1440 x 1080 pixels. Wide-field contact fundus photograph of an infant
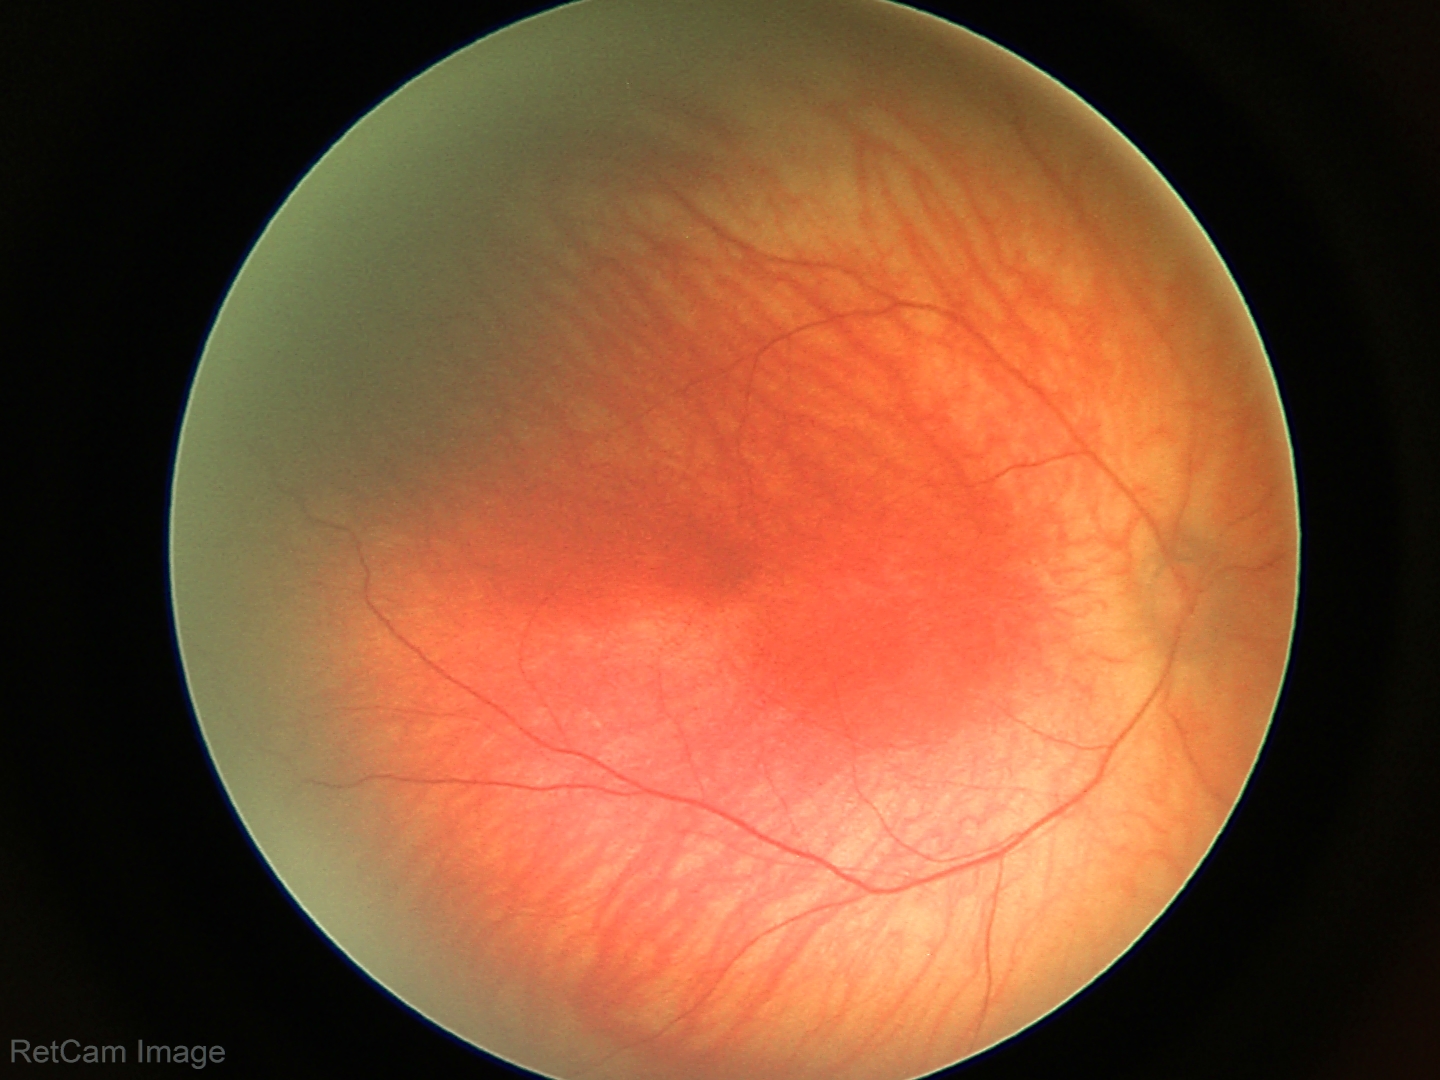

Examination with physiological retinal findings.